Color fundus photograph · 45 degree fundus photograph · 848 by 848 pixels:
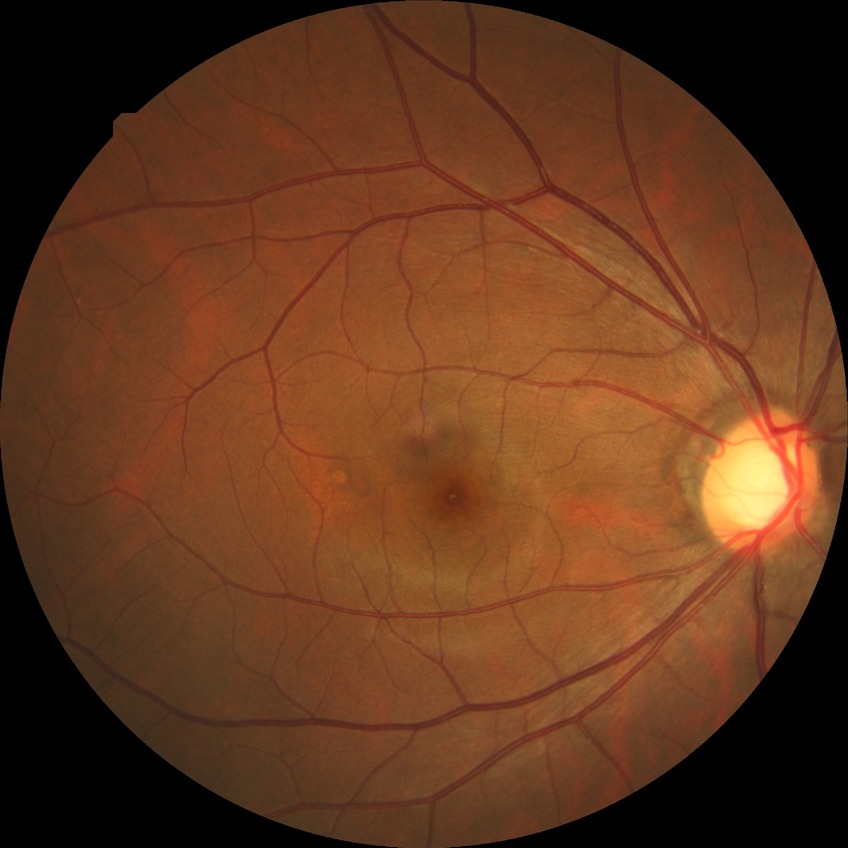 Annotations:
– diabetic retinopathy (DR) — no diabetic retinopathy (NDR)